Wide-field contact fundus photograph of an infant; Clarity RetCam 3, 130° FOV; 640 x 480 pixels:
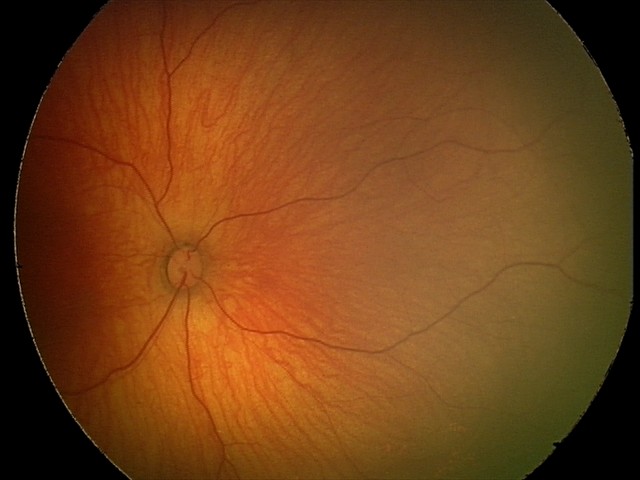
Assessment = normal retinal appearance